CFP; 848 by 848 pixels — 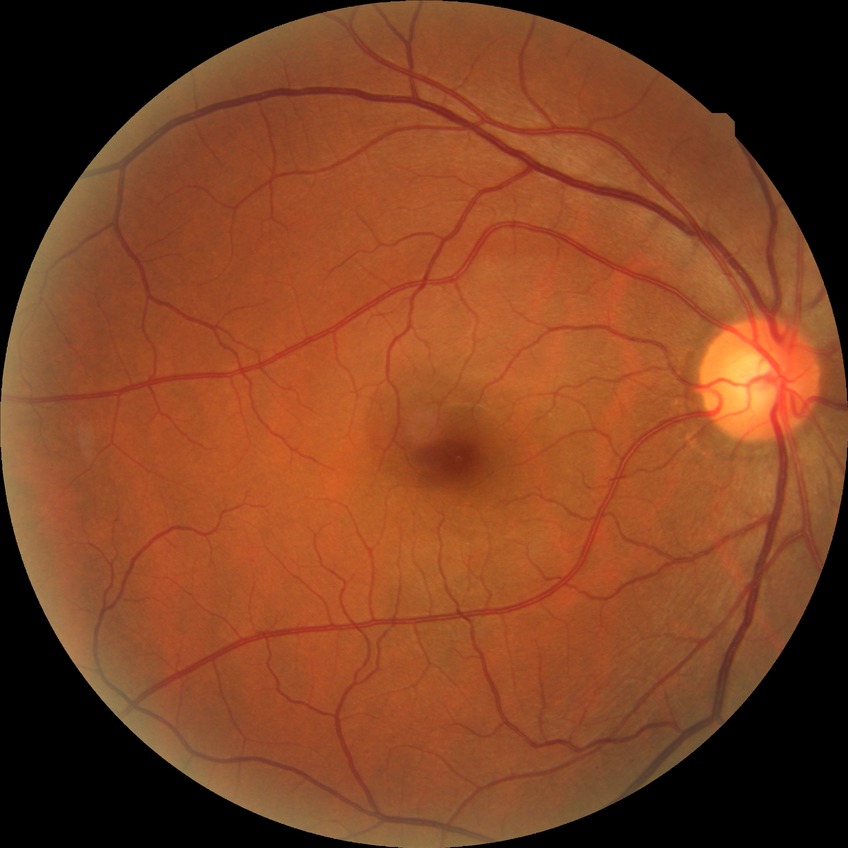 {"davis_grade": "no diabetic retinopathy (NDR)"}